CFP; 45° FOV — 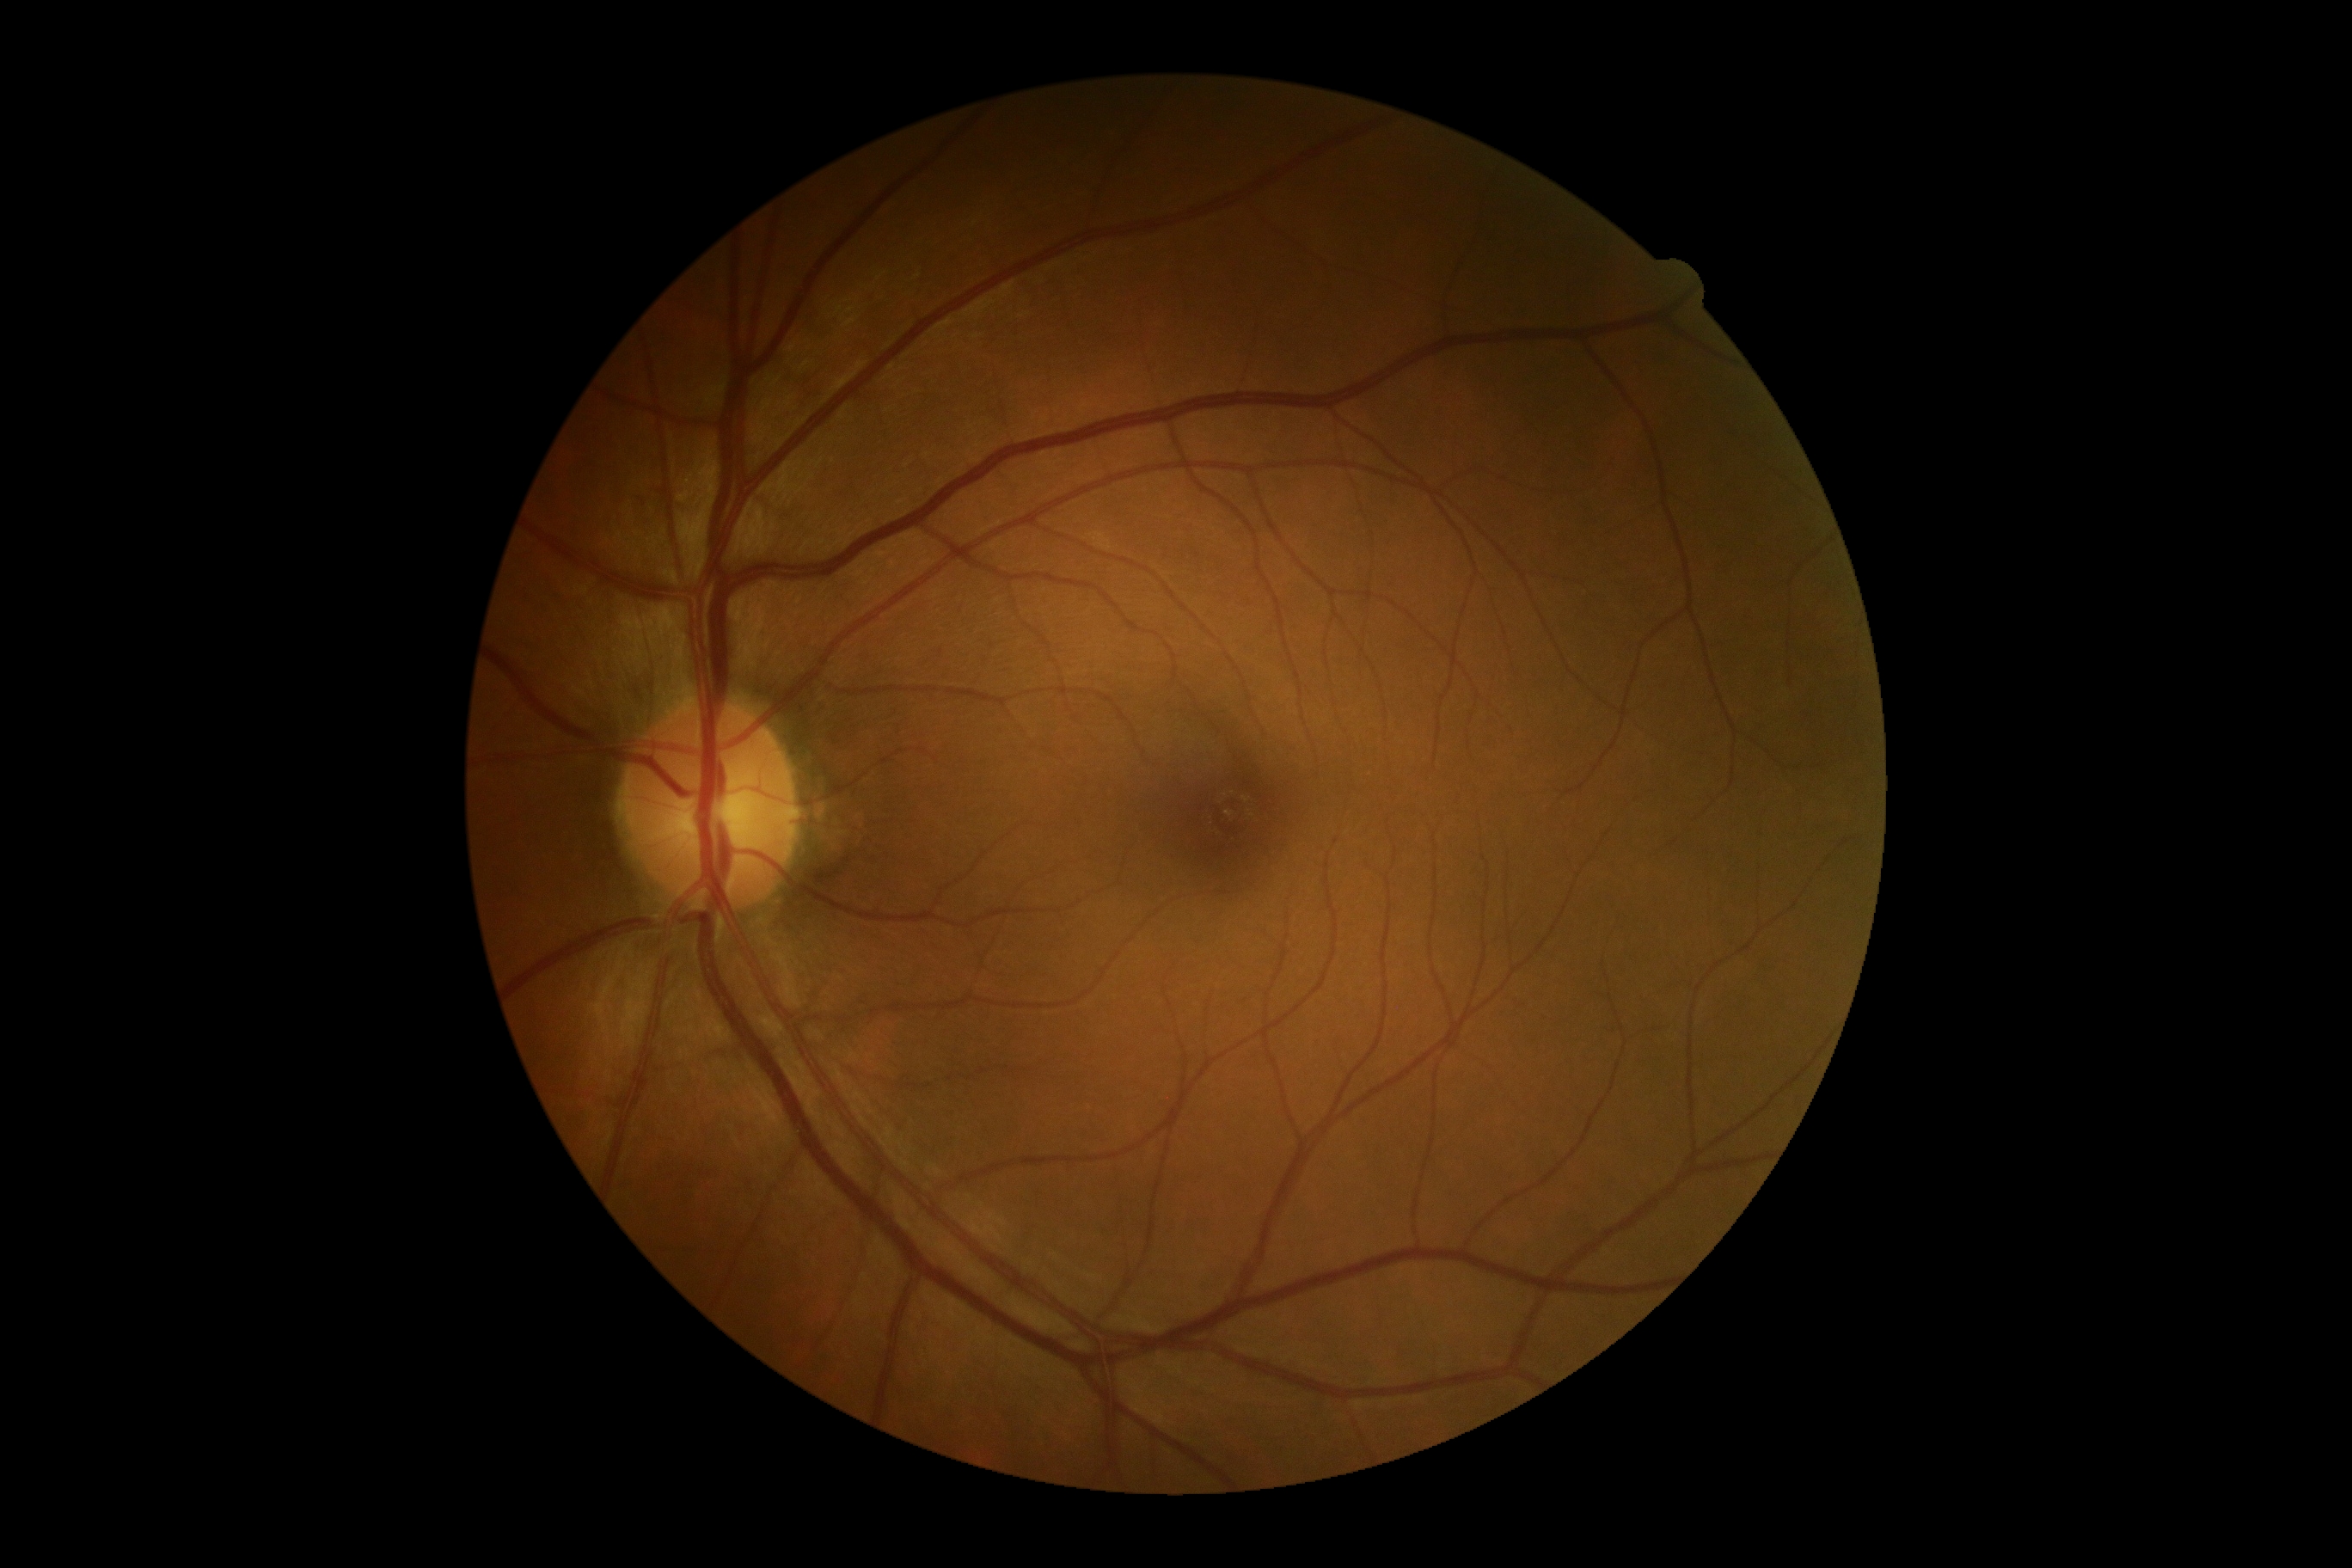 DR severity: no apparent retinopathy (grade 0). No signs of diabetic retinopathy.